Acquired on the Clarity RetCam 3 · RetCam wide-field infant fundus image:
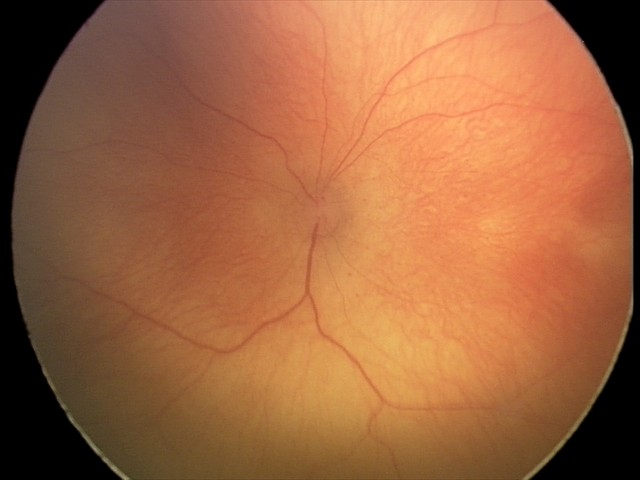 Q: What is the diagnosis from this examination?
A: ROP stage 2
Q: Plus disease status?
A: no plus disease